NIDEK AFC-230 — 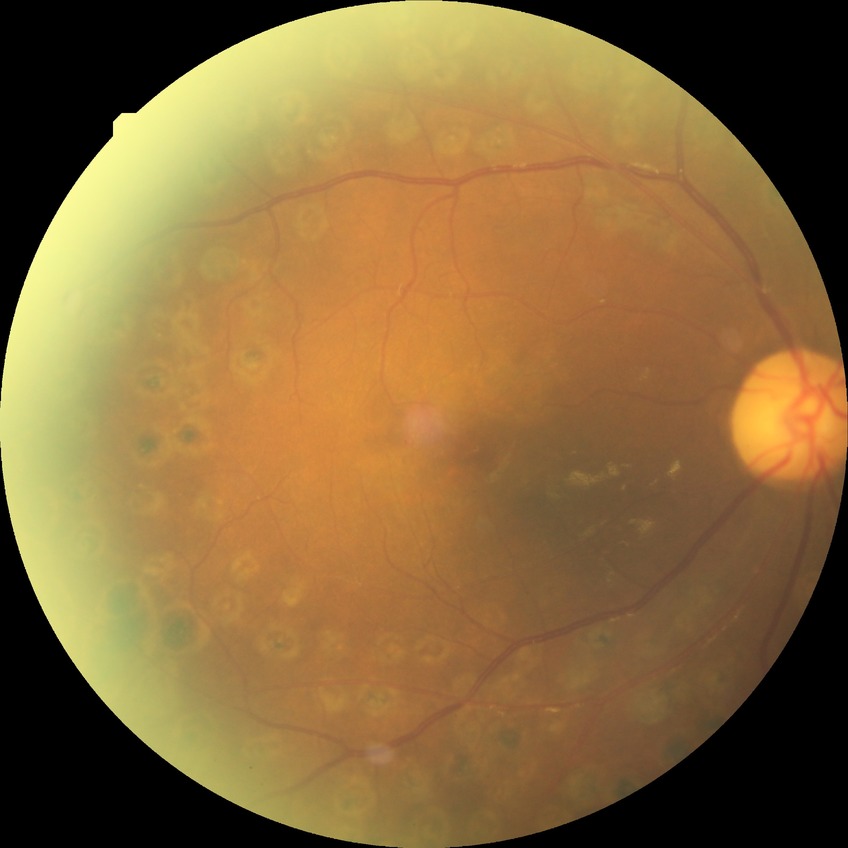 davis_grade: proliferative diabetic retinopathy